45-degree field of view
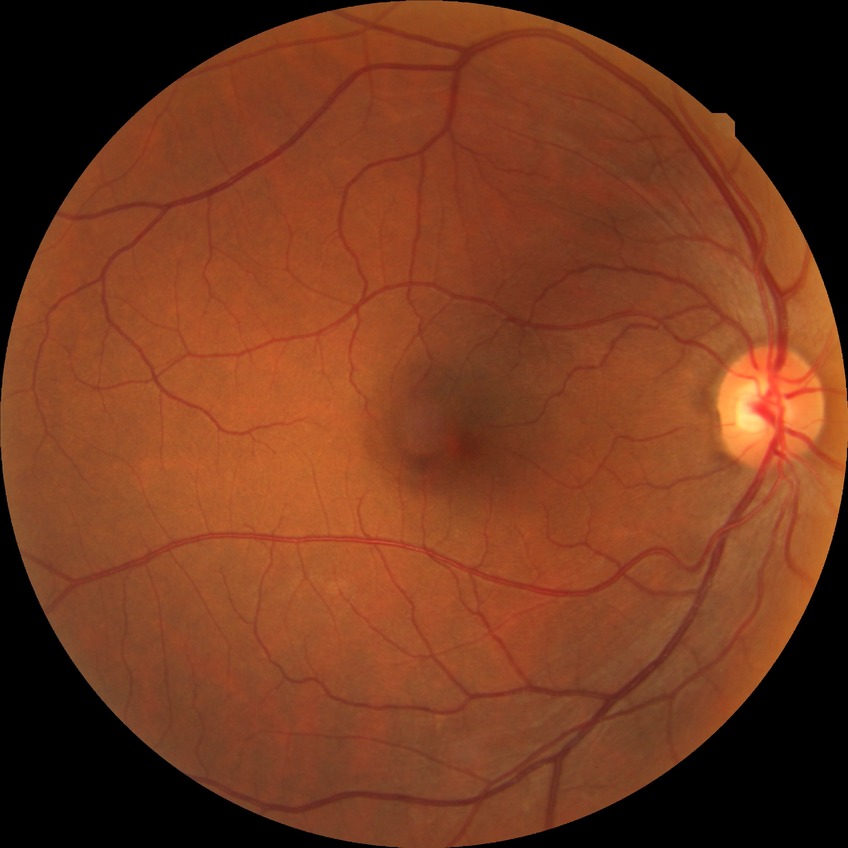

Modified Davis grade is NDR.